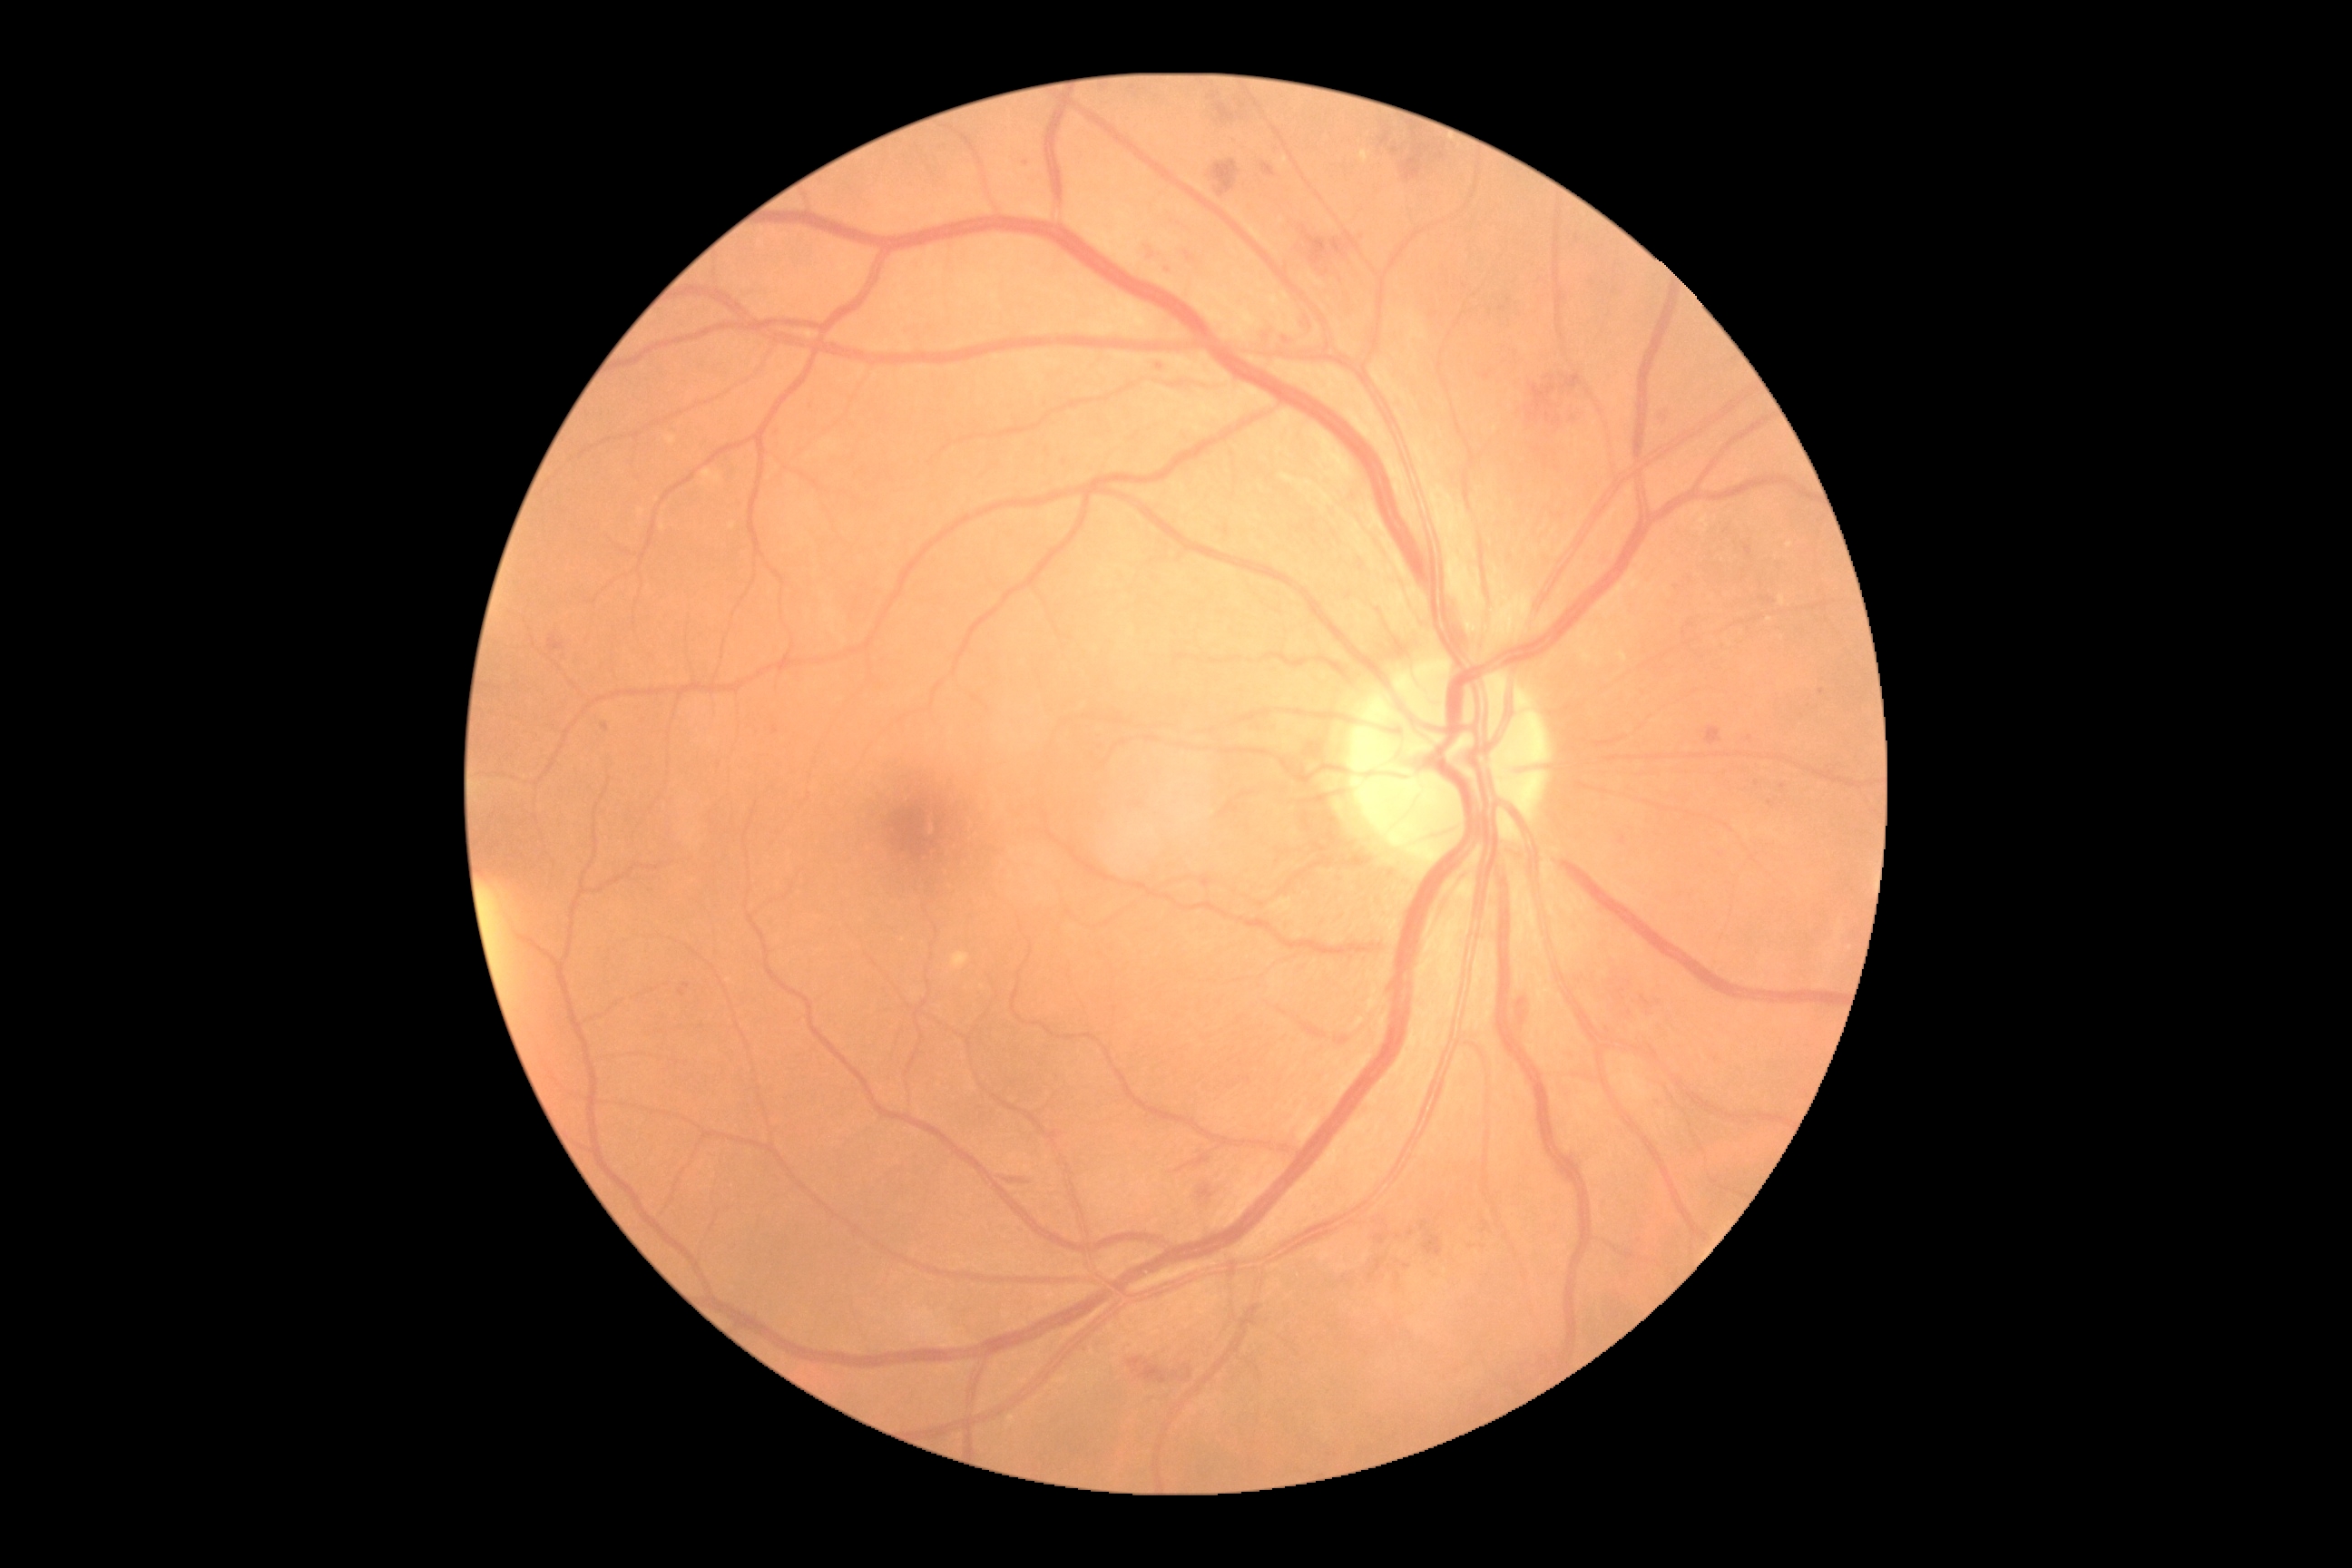

Annotations:
– diabetic retinopathy severity — grade 2 (moderate NPDR)
– DR class — non-proliferative diabetic retinopathy